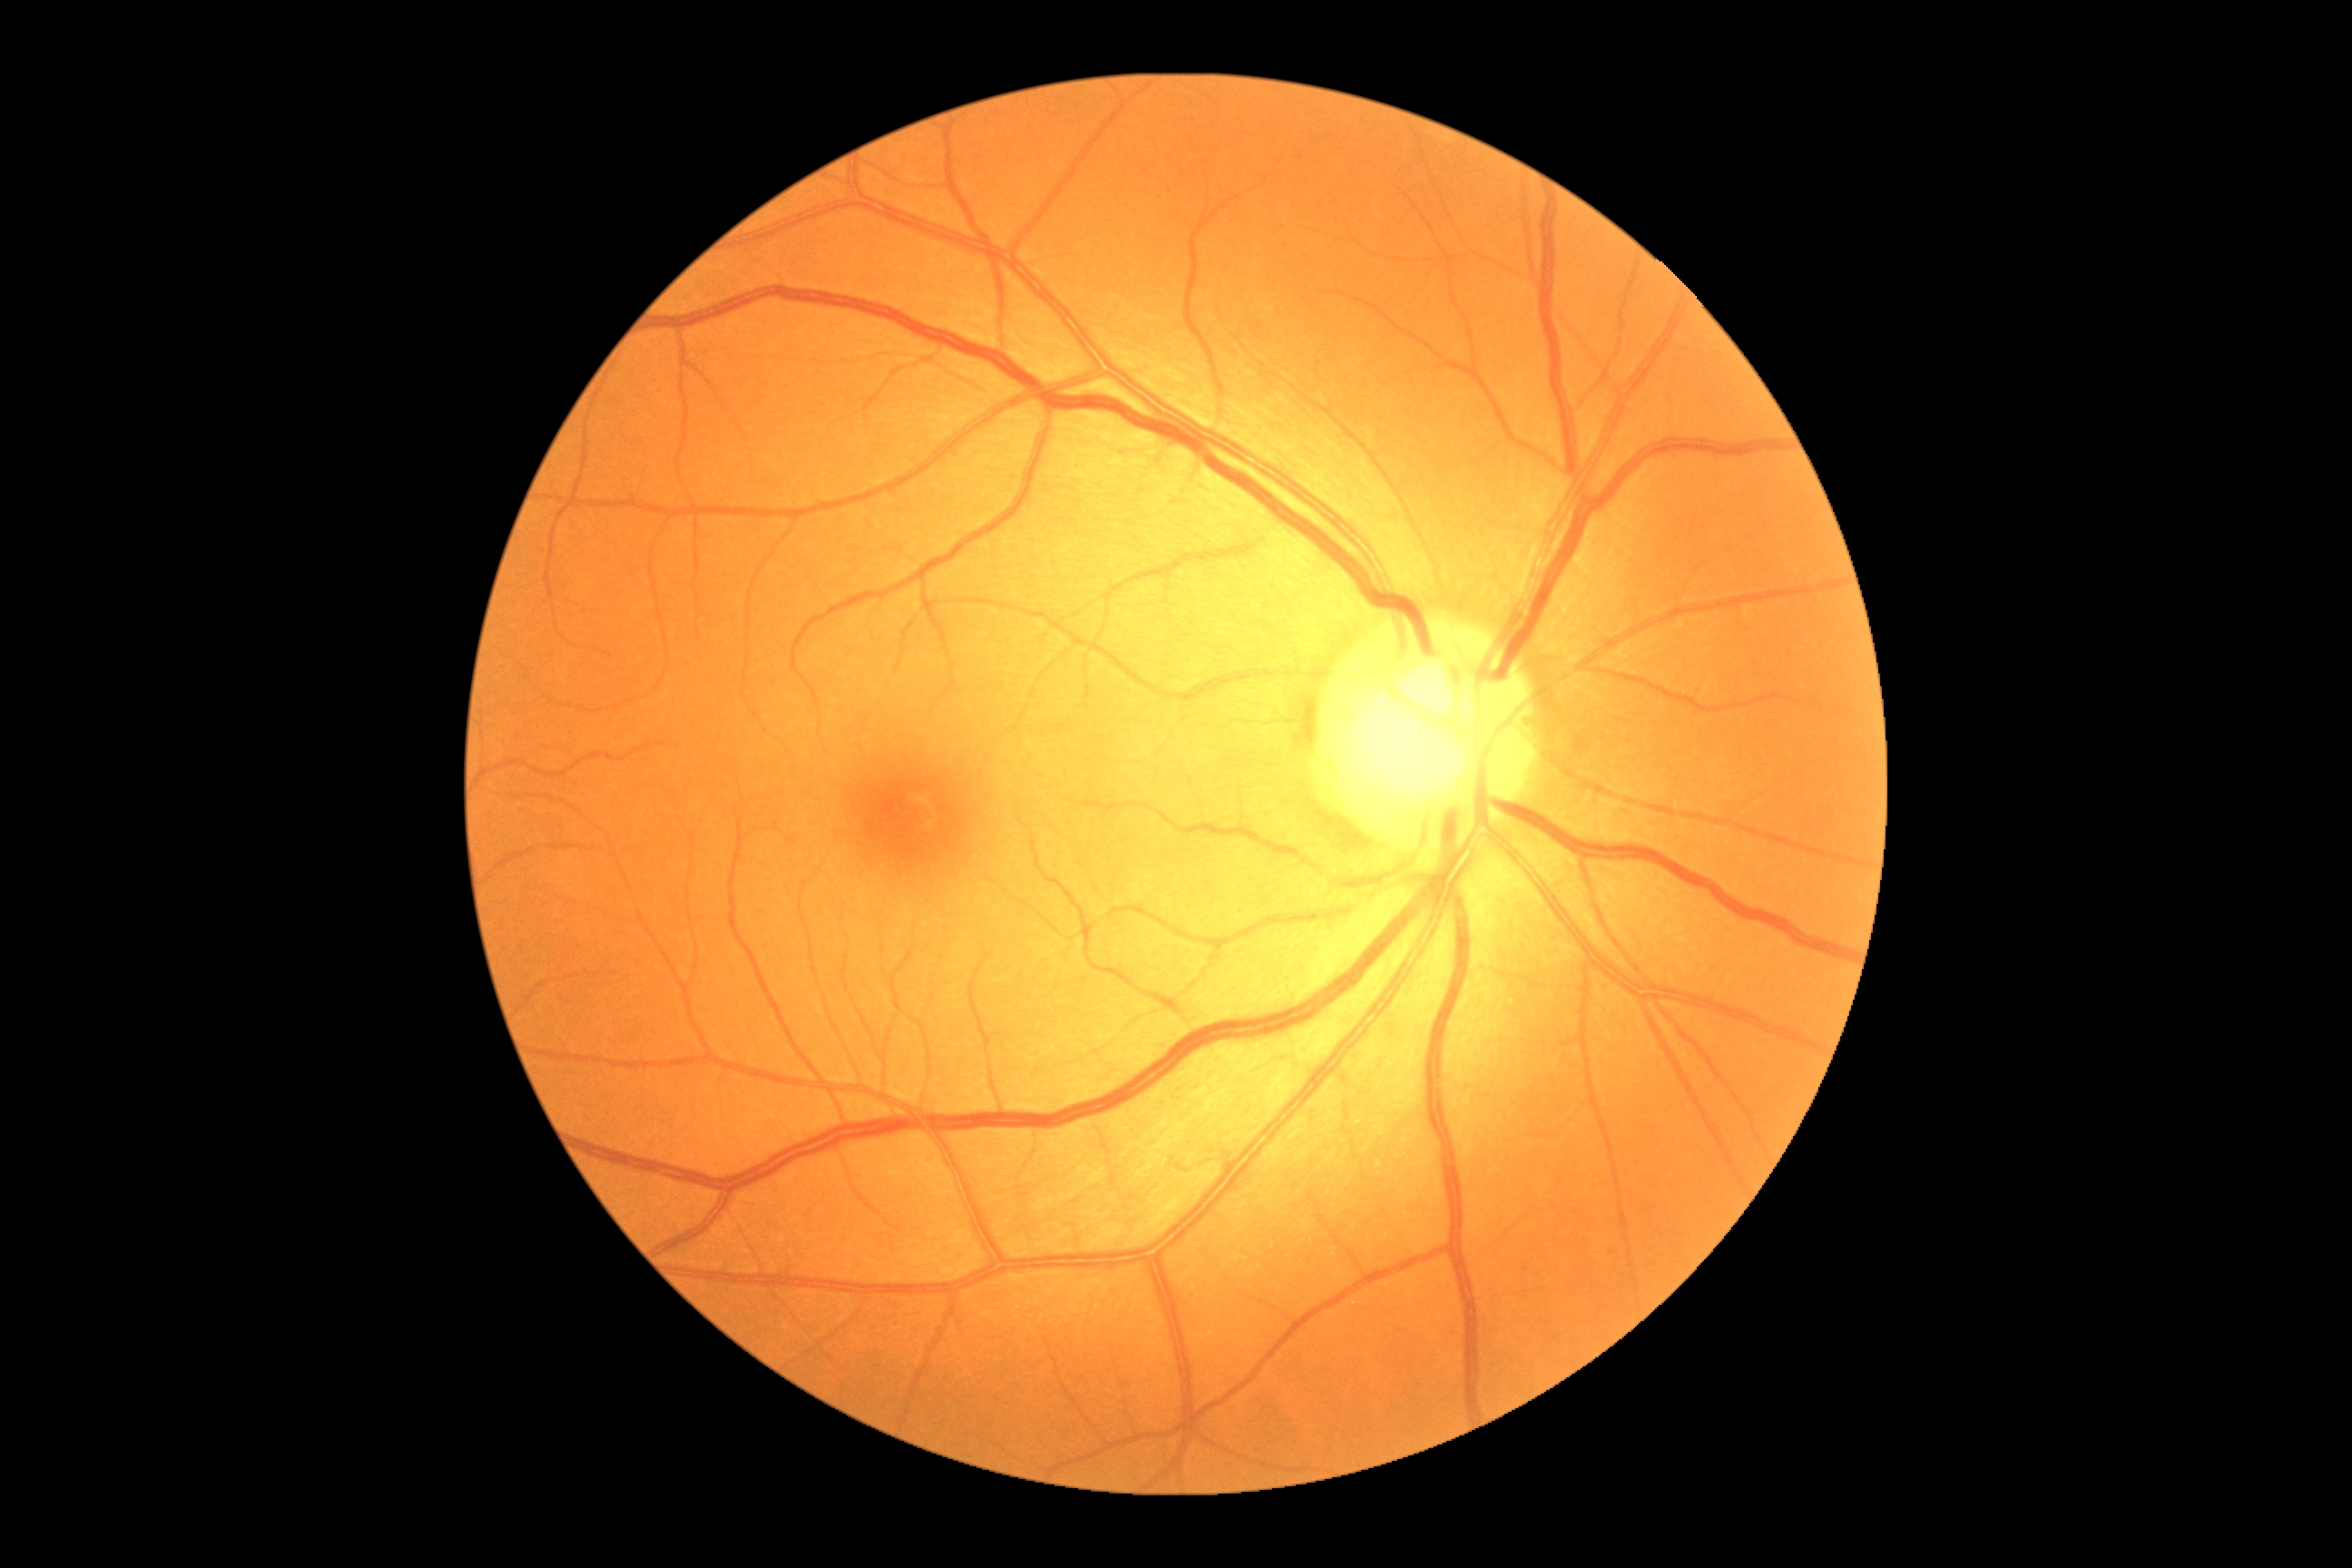

DR severity is grade 0 (no apparent retinopathy).